Graded on the modified Davis scale:
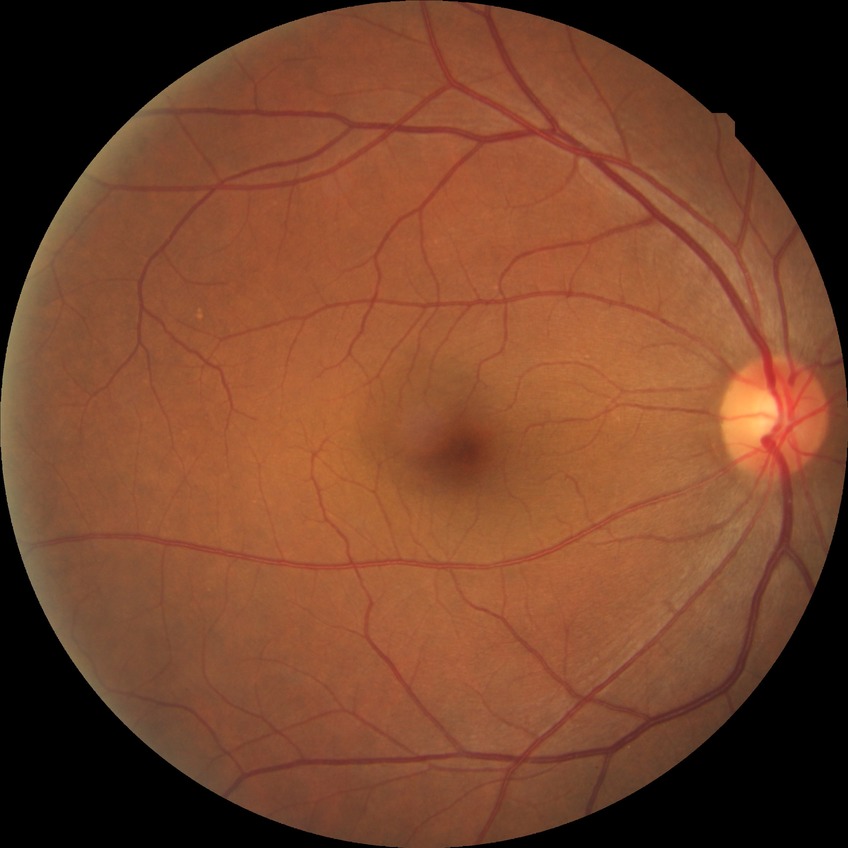

DR severity@NDR.